Color fundus photograph · image size 2352x1568 — 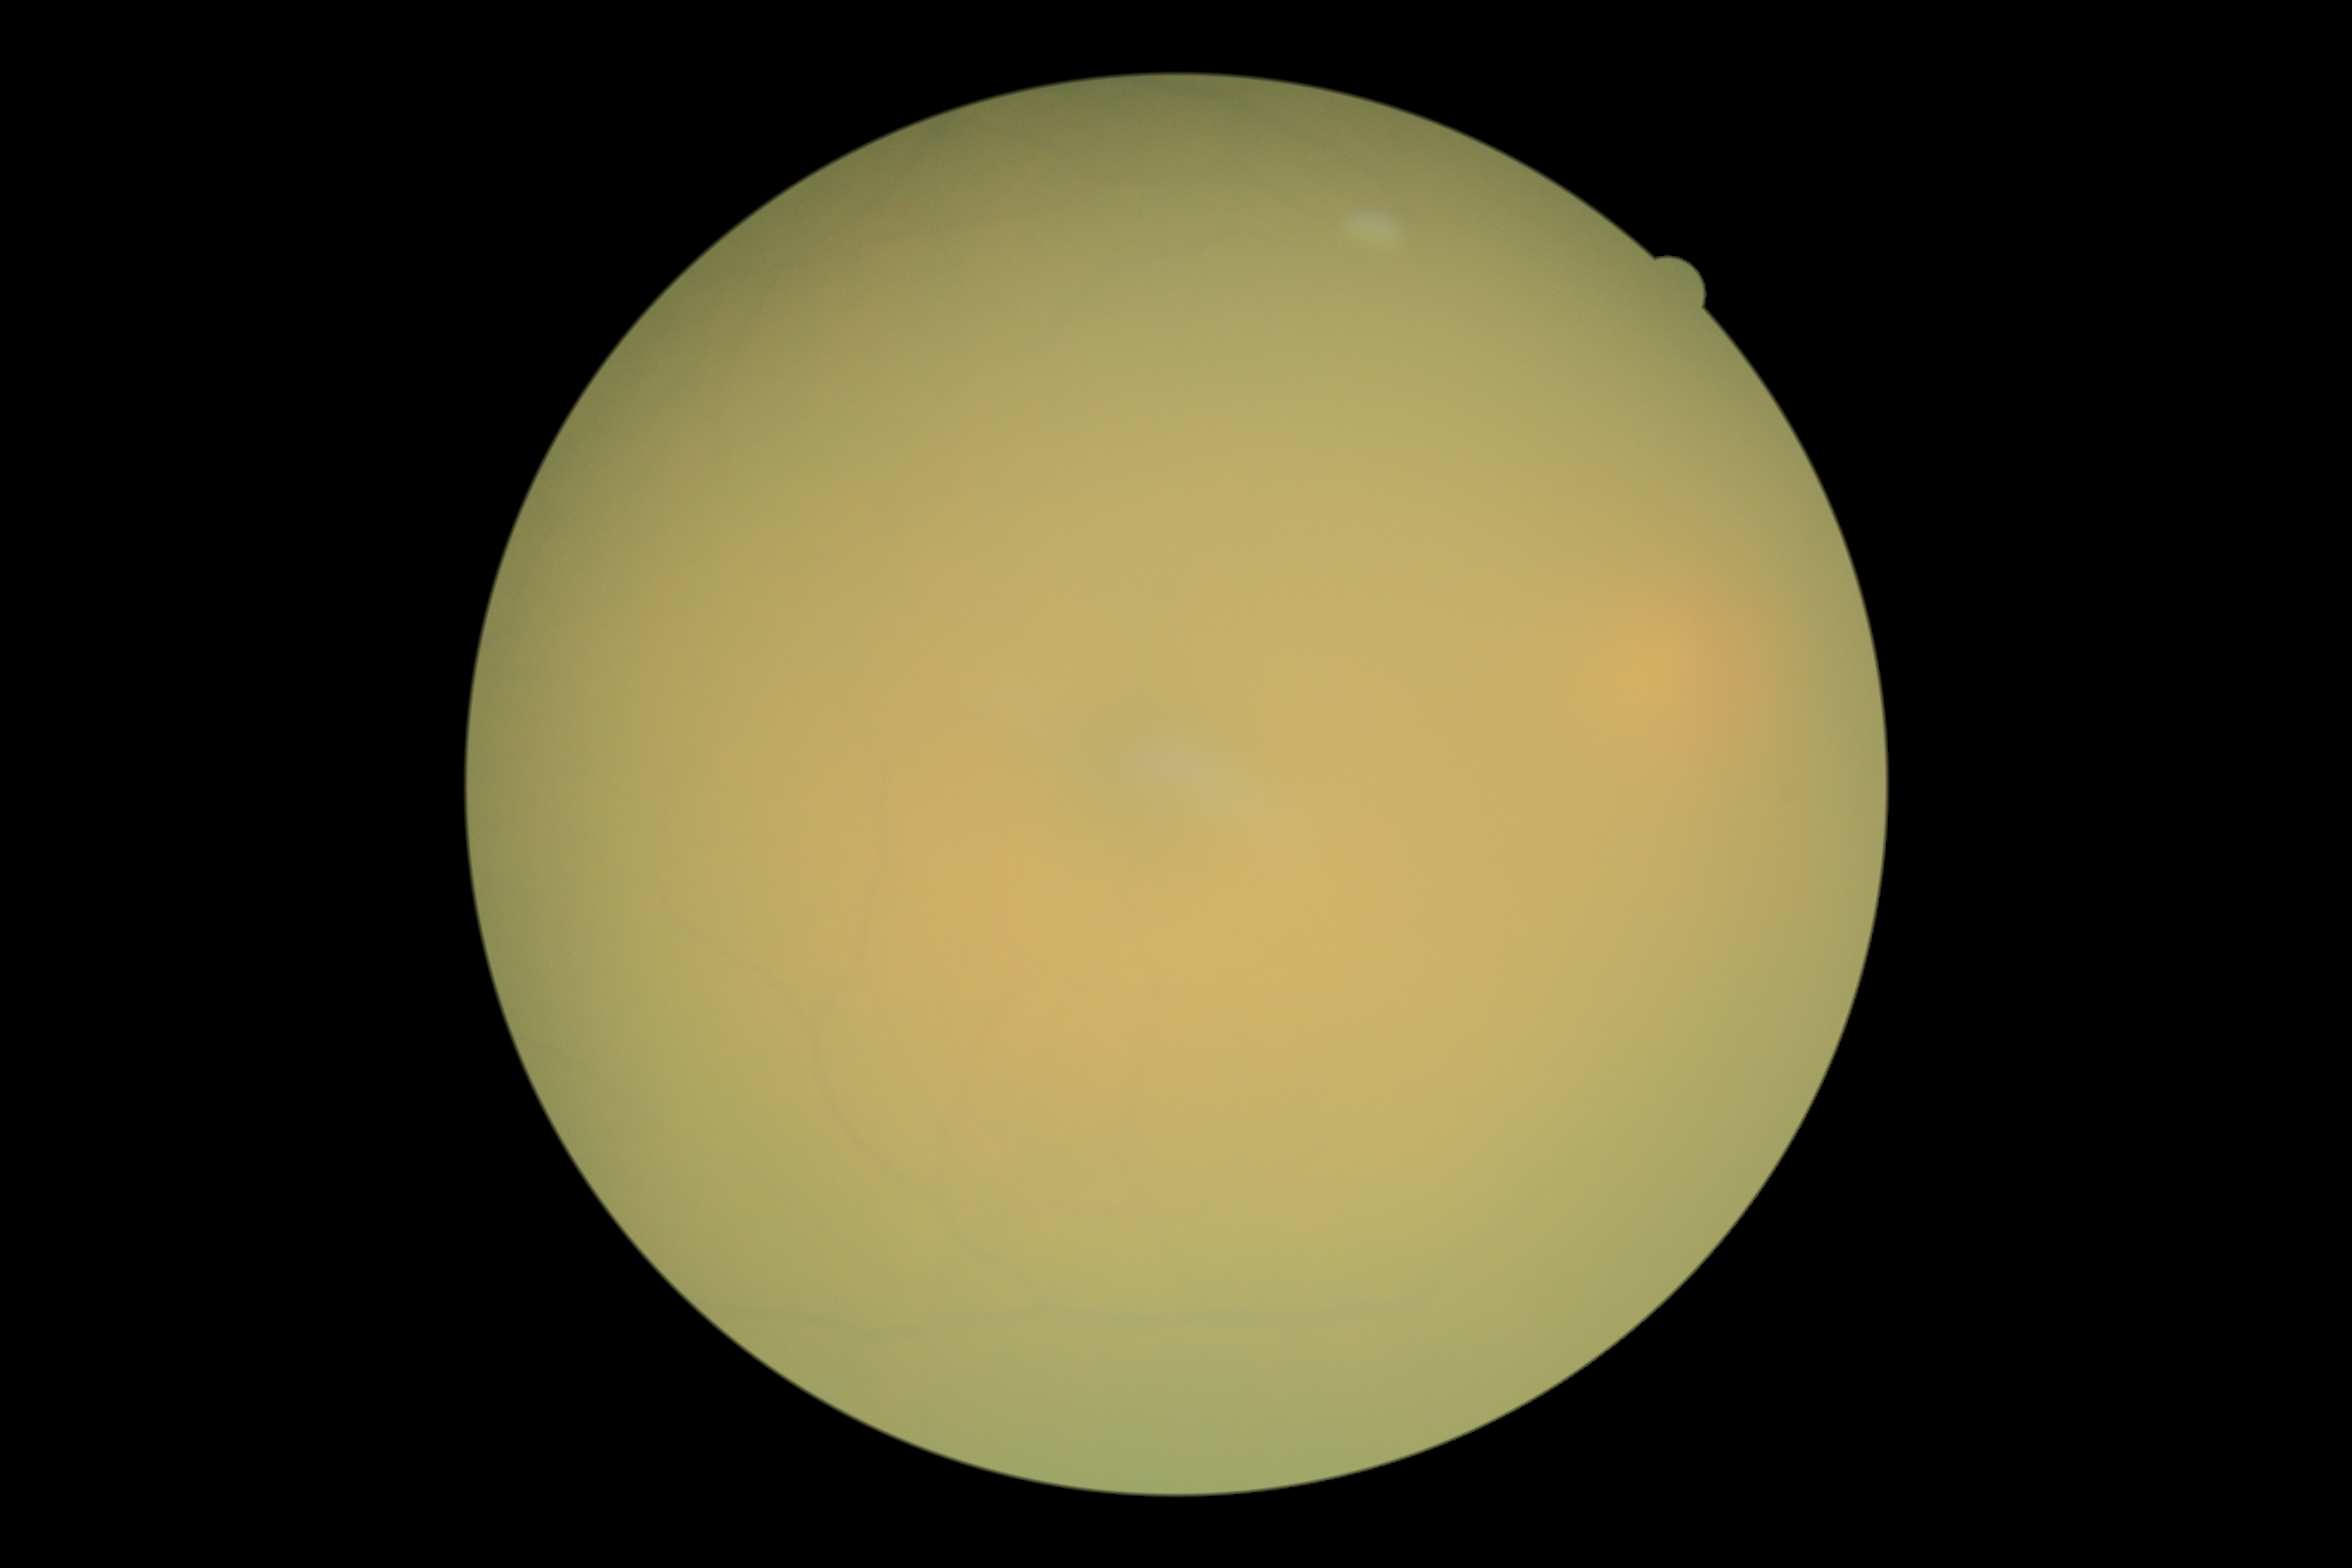

{
  "dr_grade": "ungradable due to poor image quality",
  "quality": "insufficient"
}